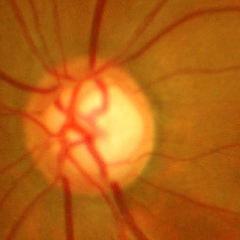 This fundus photograph shows advanced-stage glaucoma. Defined as near-total cupping of the optic nerve head, with or without severe visual field loss within the central 10 degrees of fixation.